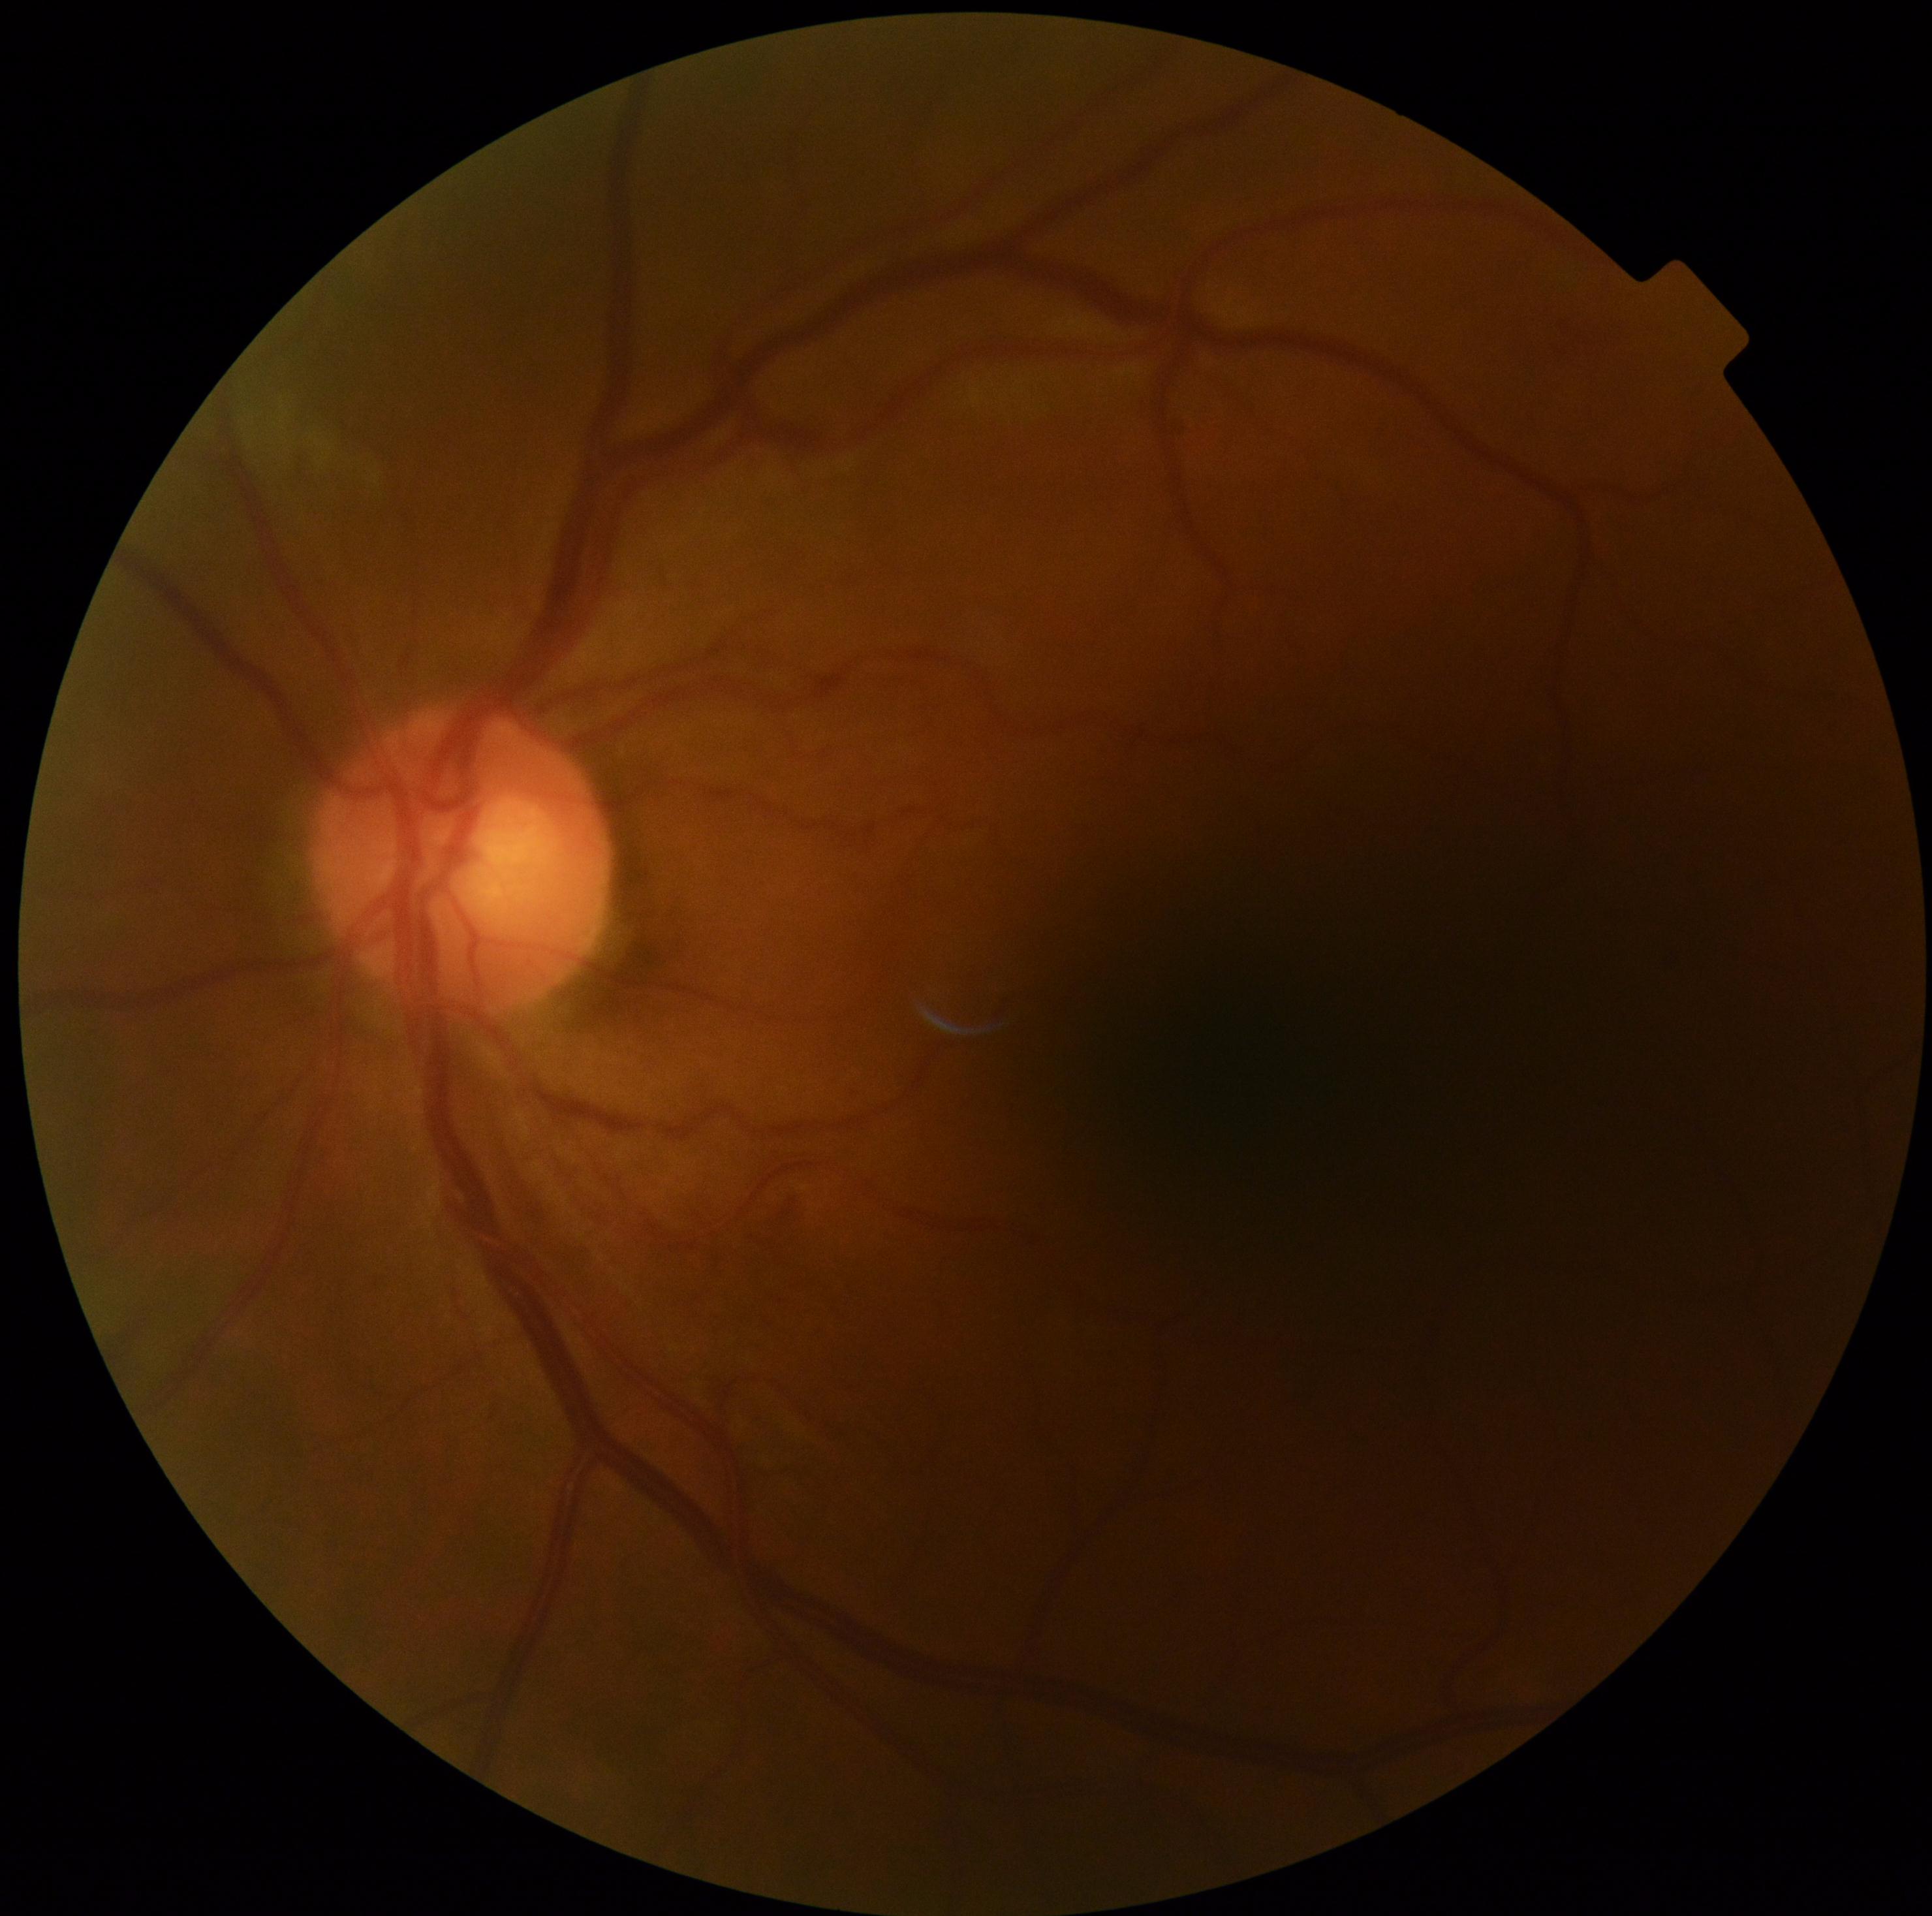 DR stage: grade 2 — more than just microaneurysms but less than severe NPDR.